Infant wide-field fundus photograph; 640x480px — 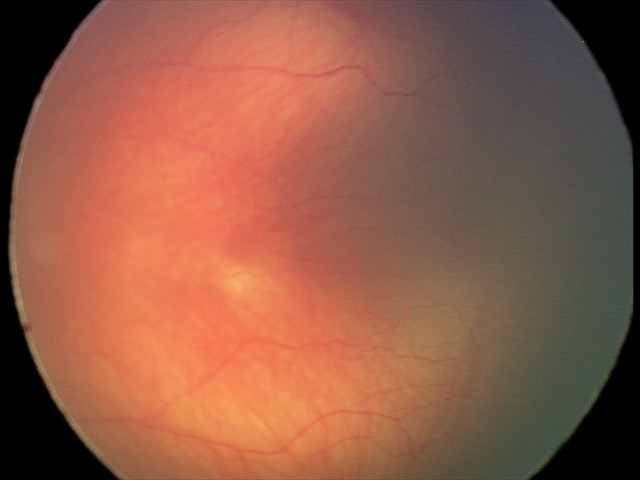

Series diagnosed as ROP stage 2.